848x848px, no pharmacologic dilation.
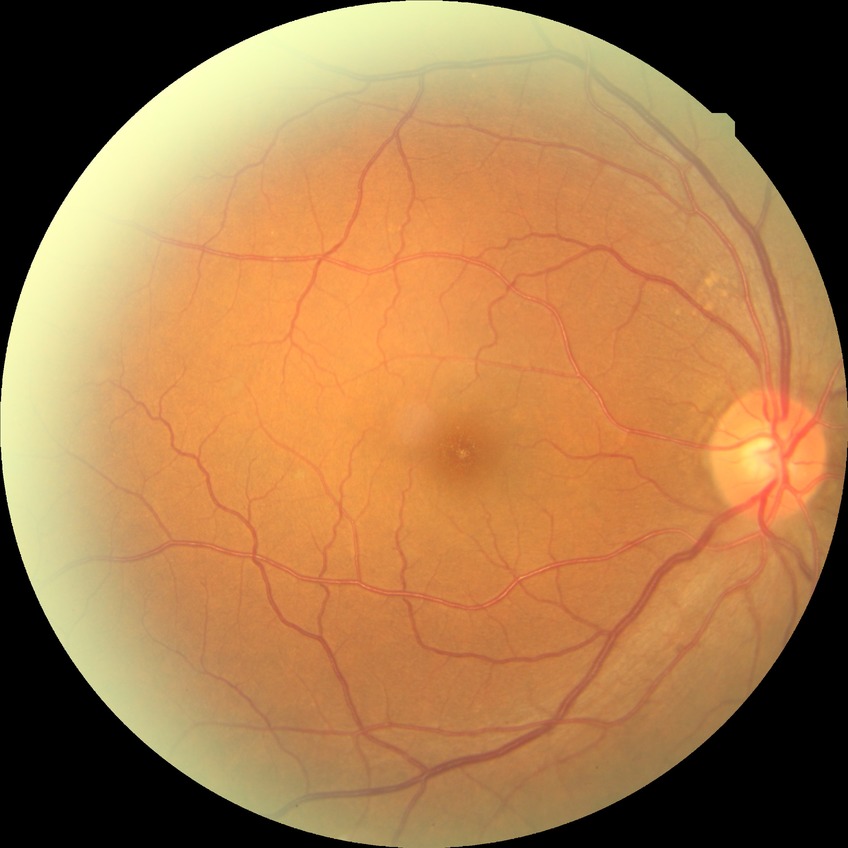

Assessment:
• Davis grade: NDR
• DR impression: no apparent DR